2352x1568; fundus photo; 45° FOV — 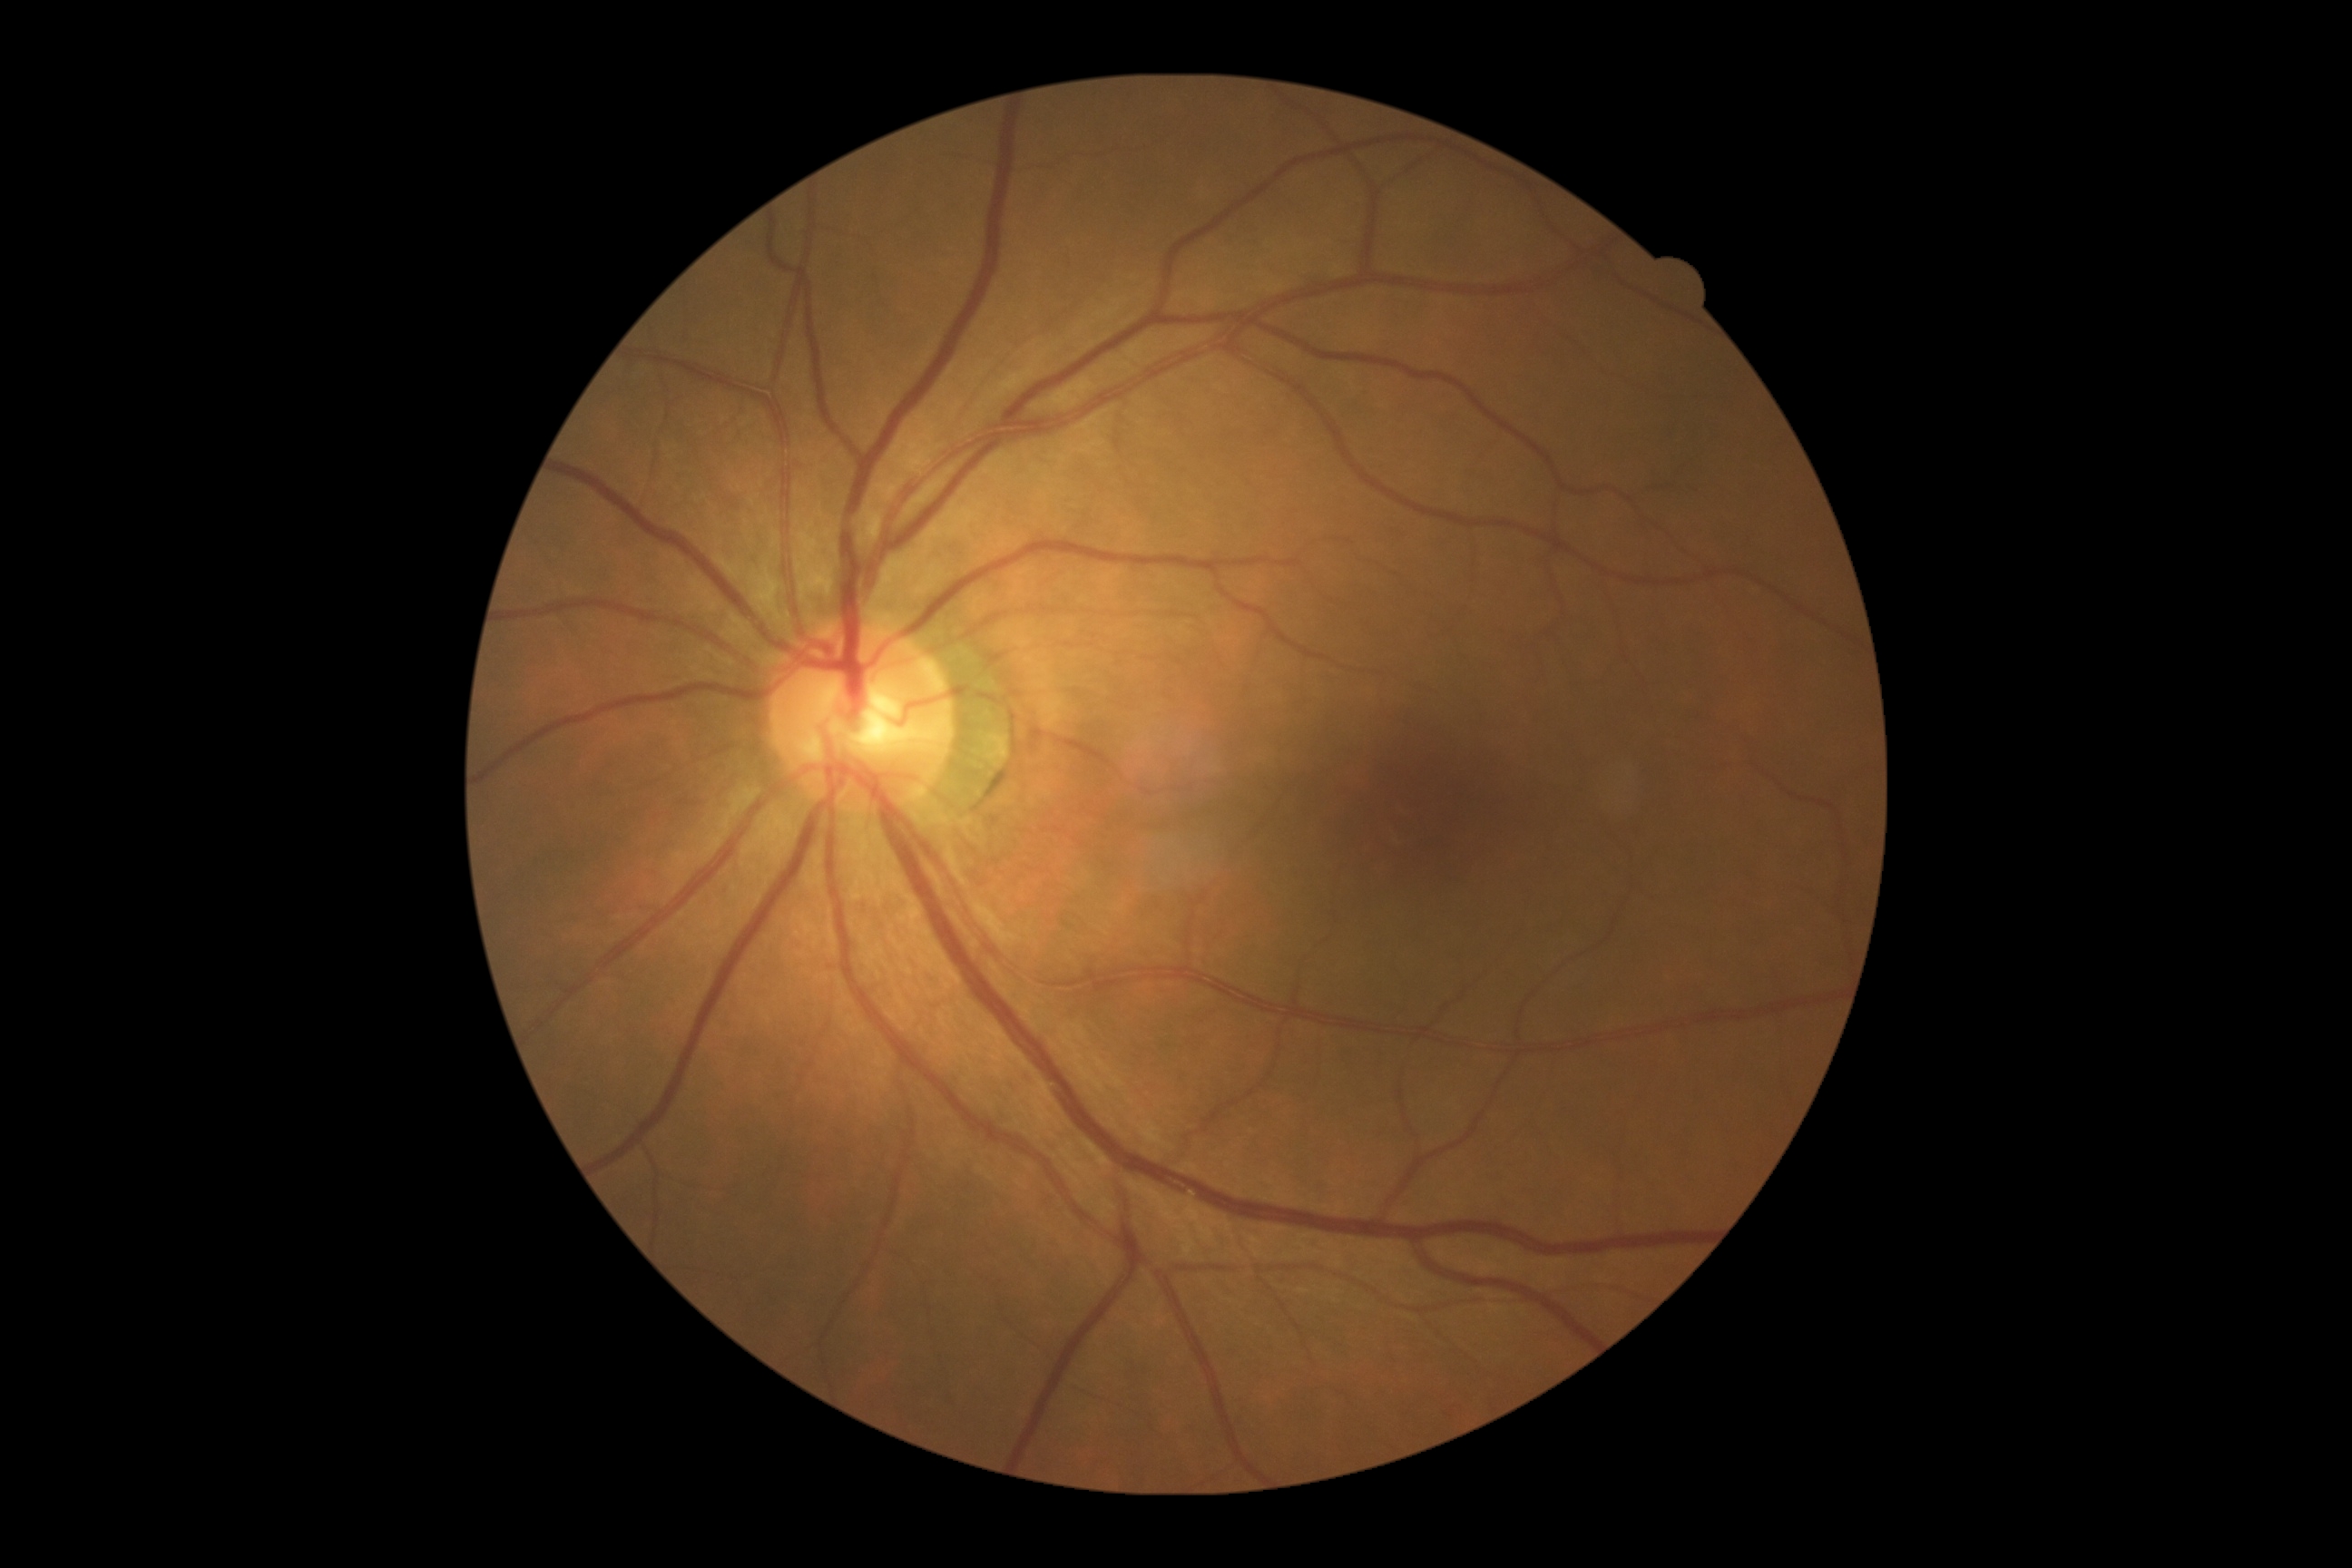
DR: grade 0 — no visible signs of diabetic retinopathy.